Without pupil dilation; modified Davis grading
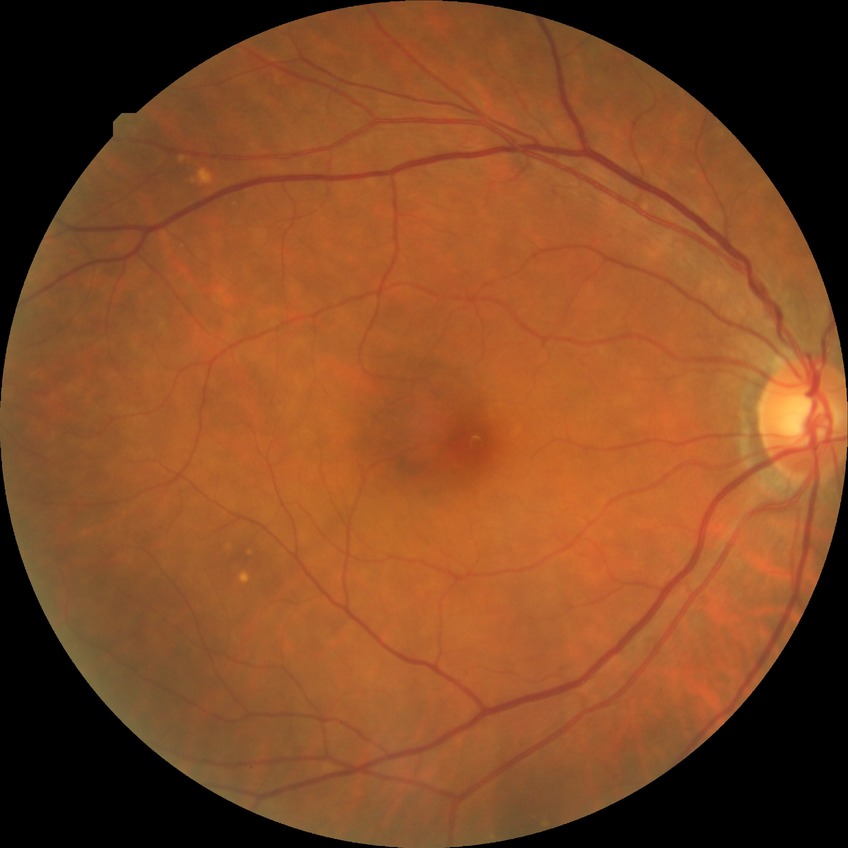 modified Davis grading = no diabetic retinopathy